45-degree field of view — 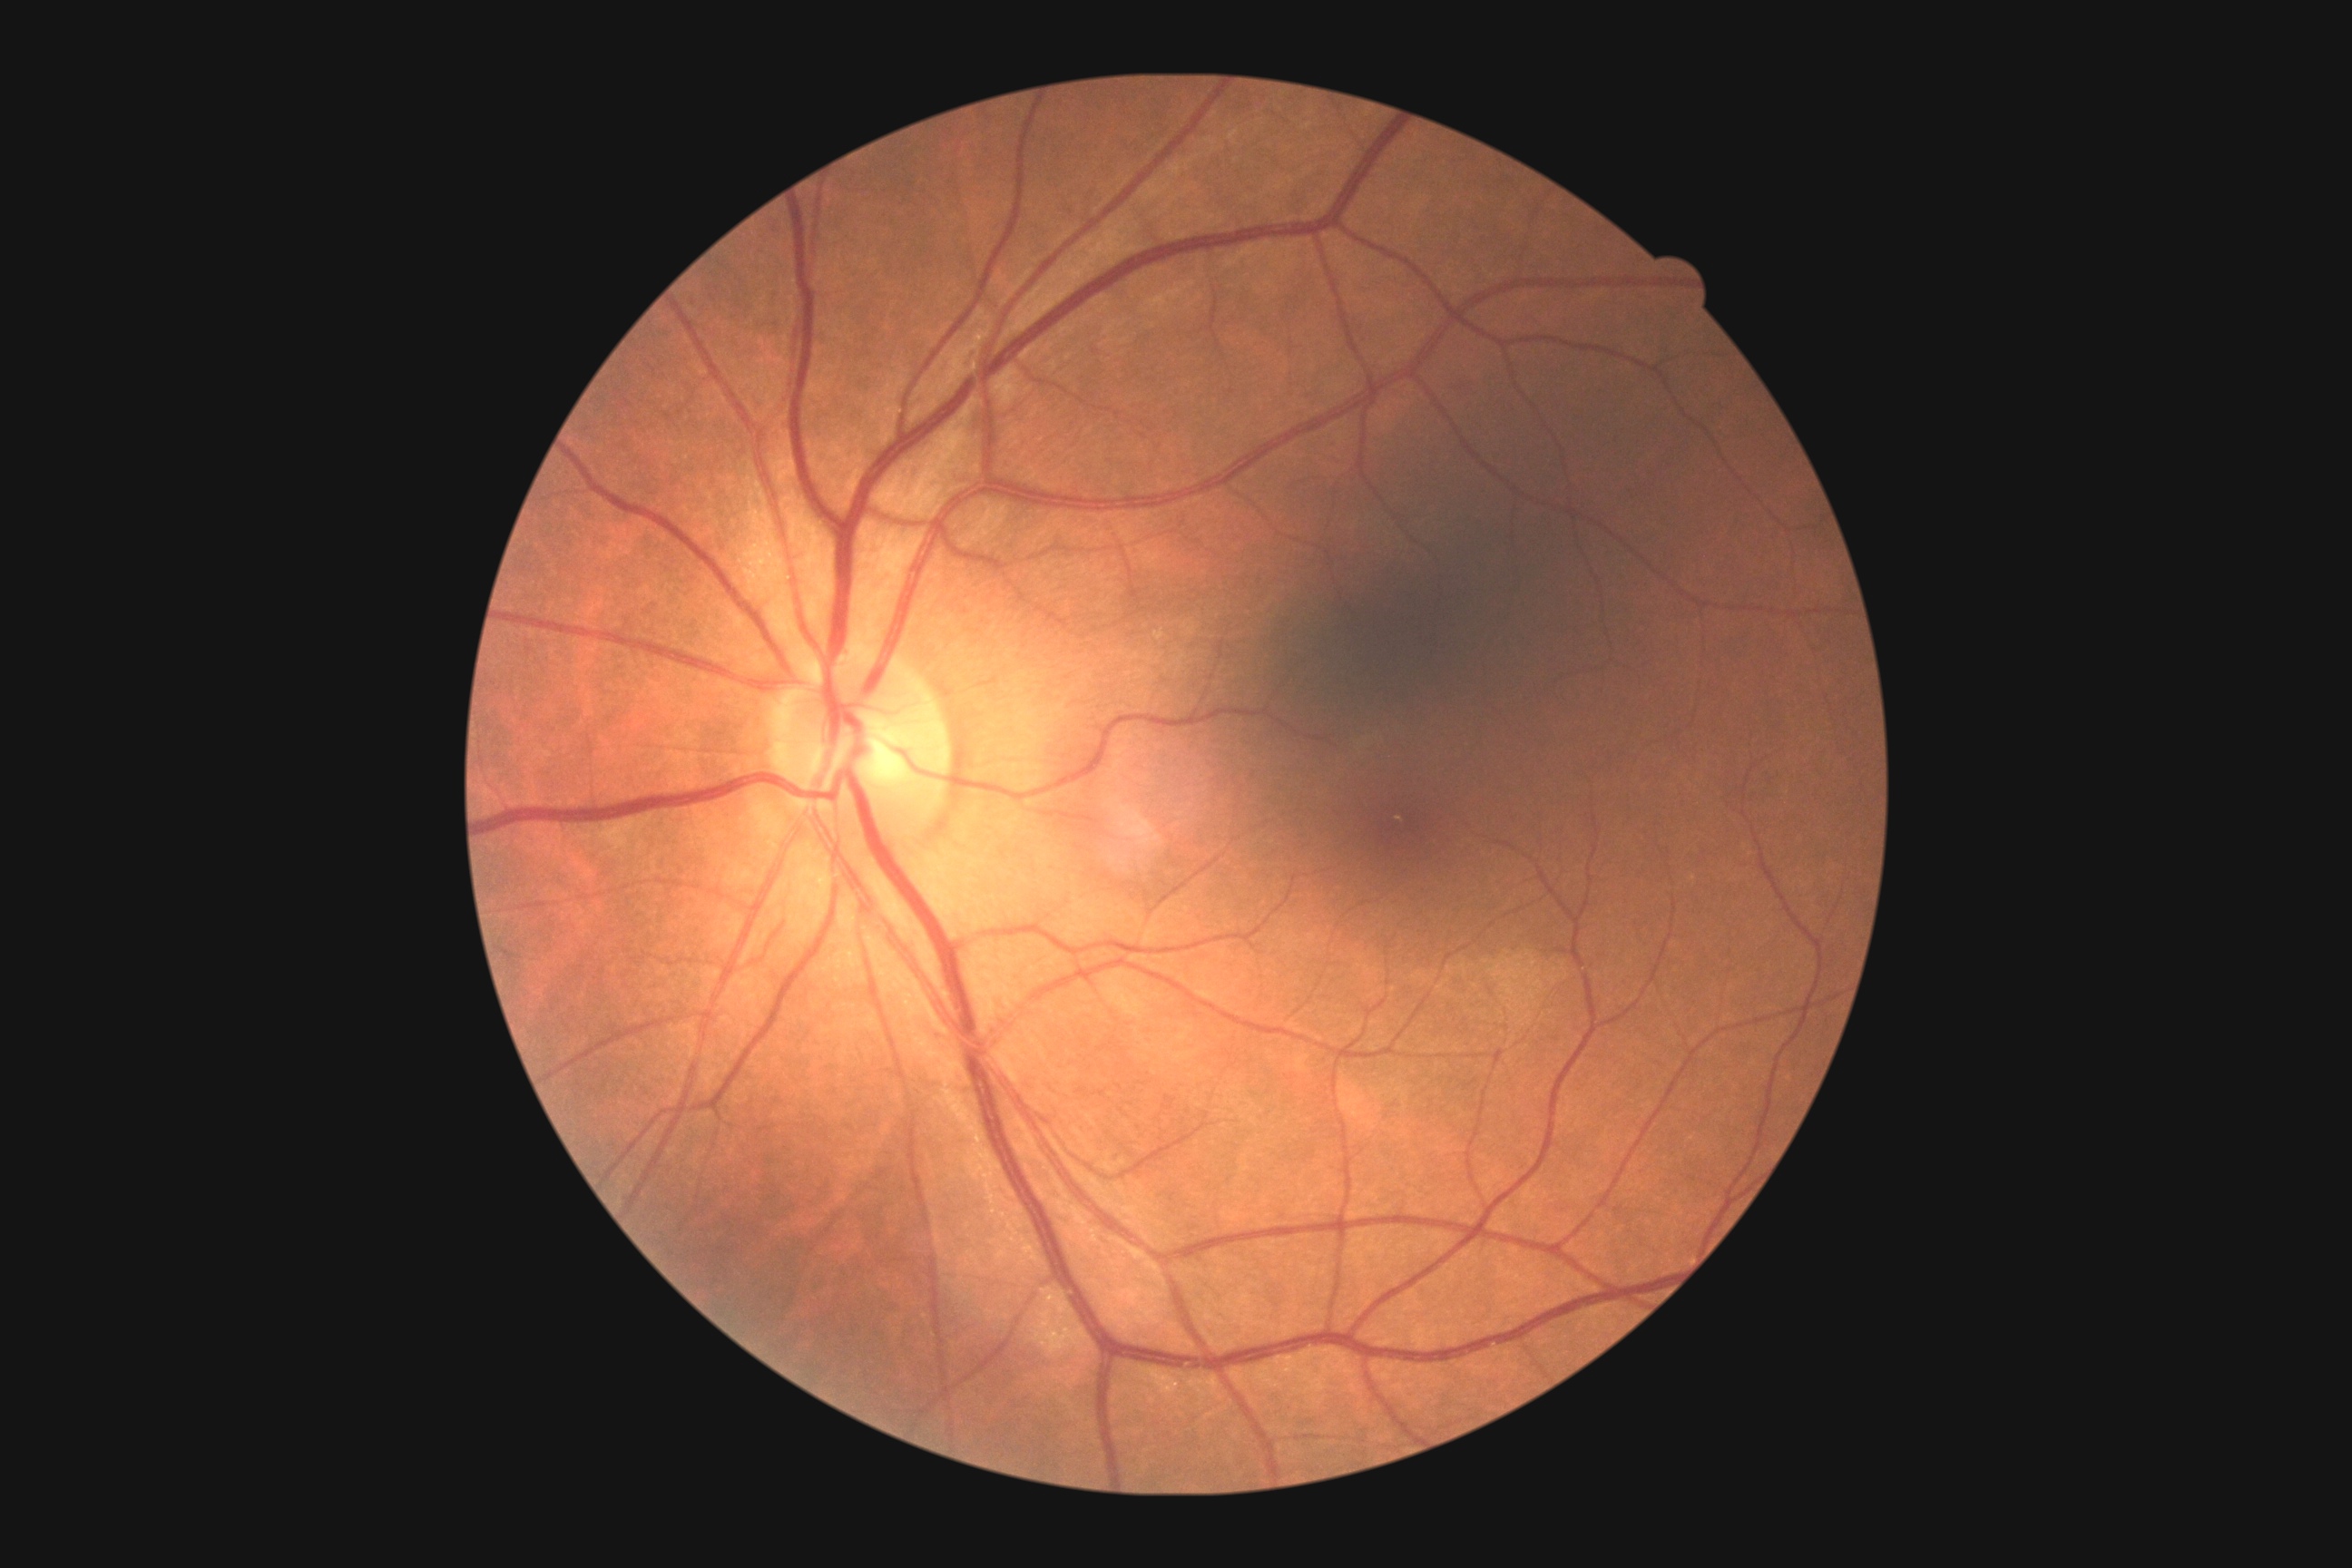

DR is no apparent diabetic retinopathy (grade 0). No DR findings.